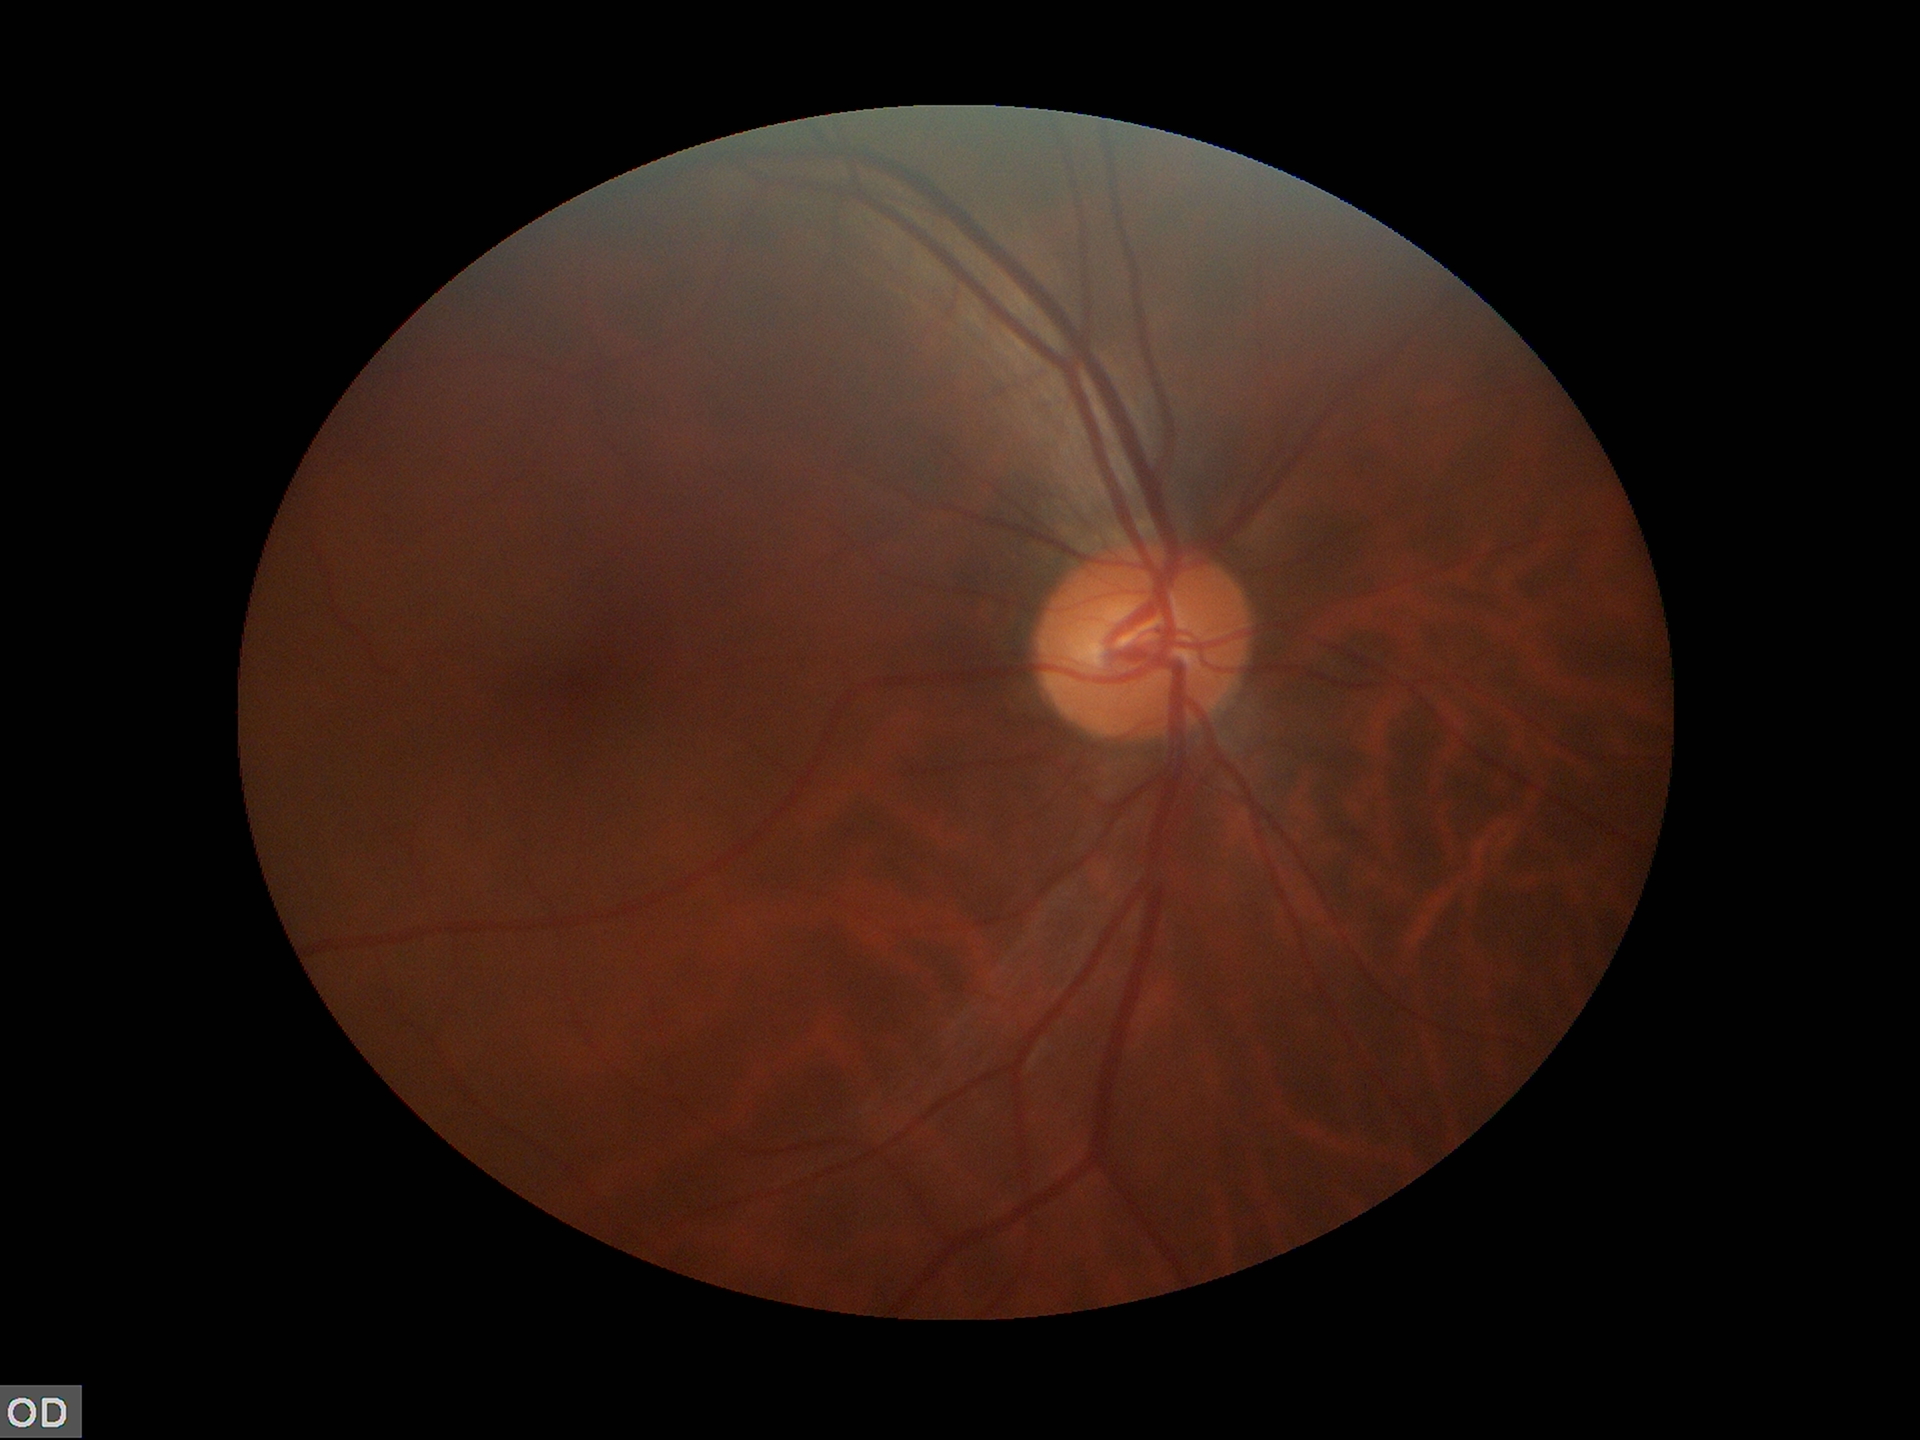
  vcdr: 0.48
  glaucoma_decision: not suspect (unanimous normal call)